Pediatric retinal photograph (wide-field) · 640x480px · camera: Clarity RetCam 3 (130° FOV).
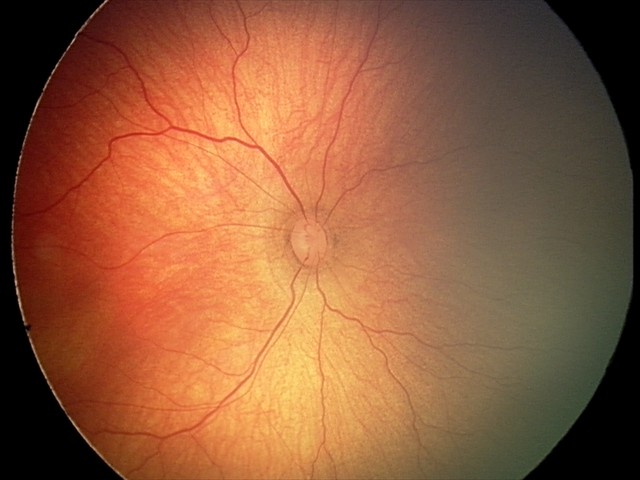 Screening series with retinopathy of prematurity stage 2.
Without plus disease.